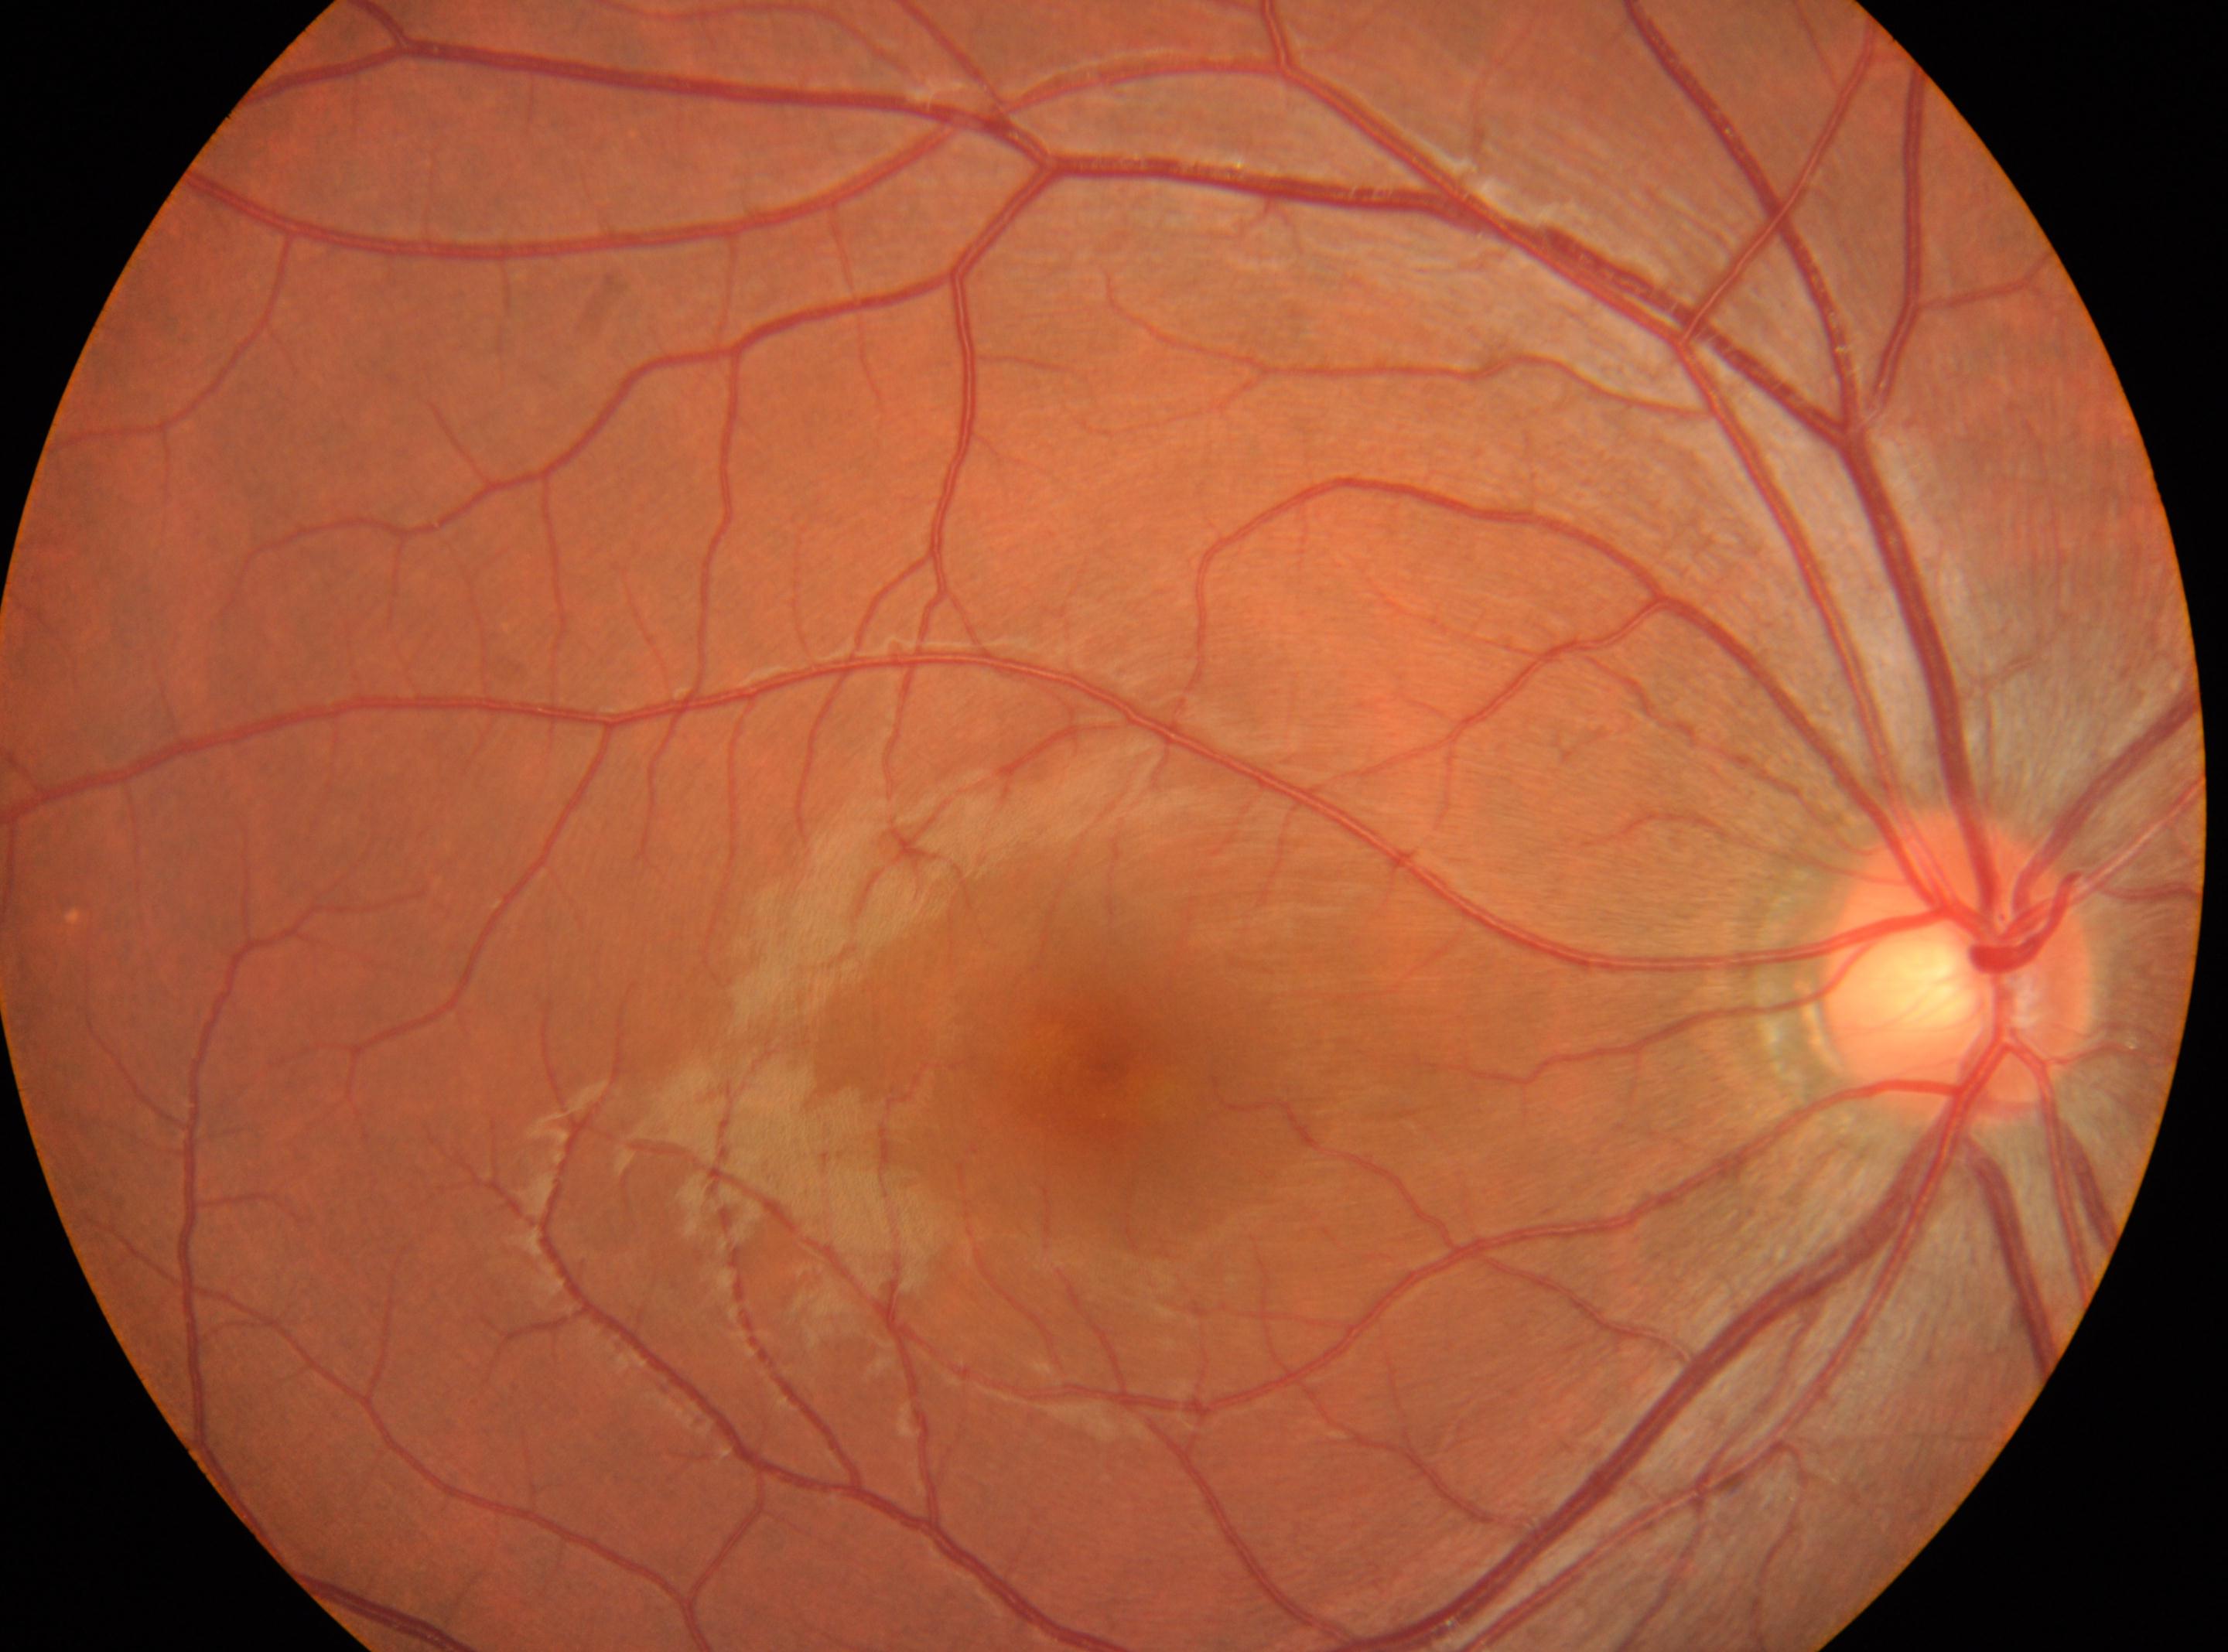

Diabetic retinopathy: 0/4. No apparent diabetic retinopathy. The image shows the right eye. Fovea: x=1106, y=1072. The ONH is at x=1959, y=970.